Image size 848x848, color fundus image — 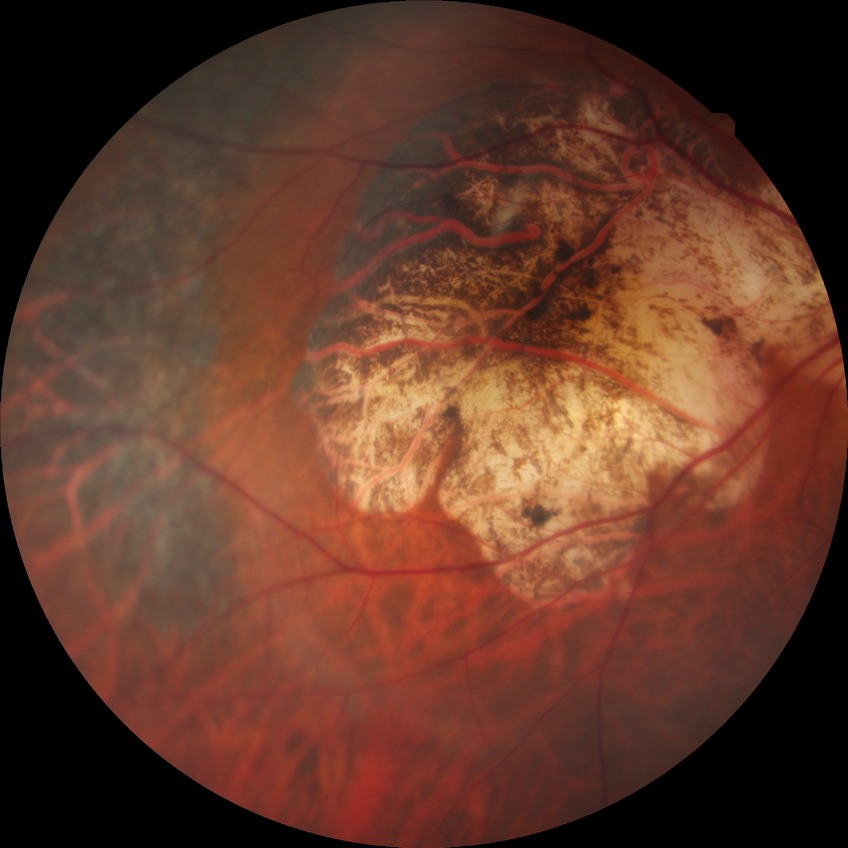
Diabetic retinopathy (DR) is SDR (simple diabetic retinopathy).